848x848, no pharmacologic dilation, 45 degree fundus photograph, NIDEK AFC-230 — 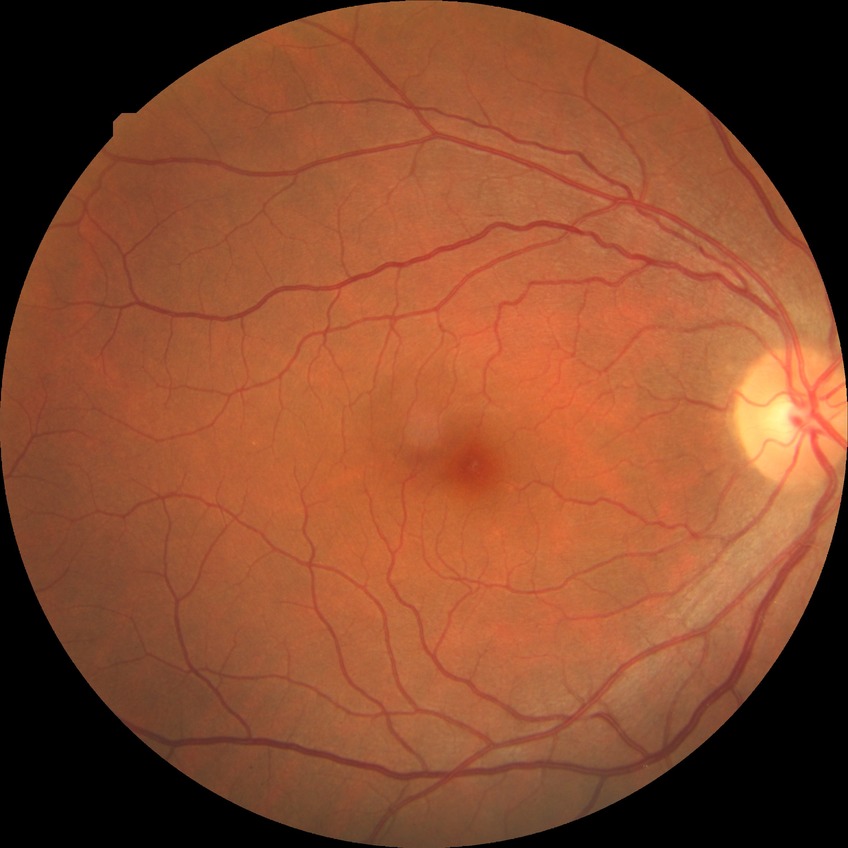
Davis grade@NDR.